Diabetic retinopathy graded by the modified Davis classification · 848 x 848 pixels — 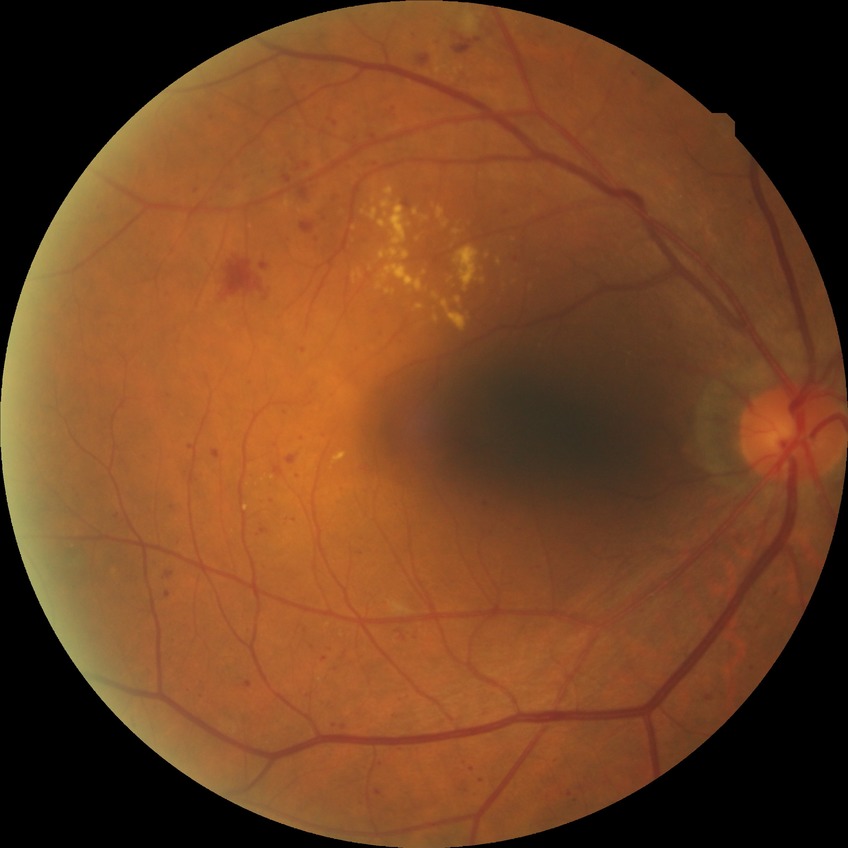
Diabetic retinopathy (DR): simple diabetic retinopathy (SDR). DR class: non-proliferative diabetic retinopathy.